Pediatric wide-field fundus photograph.
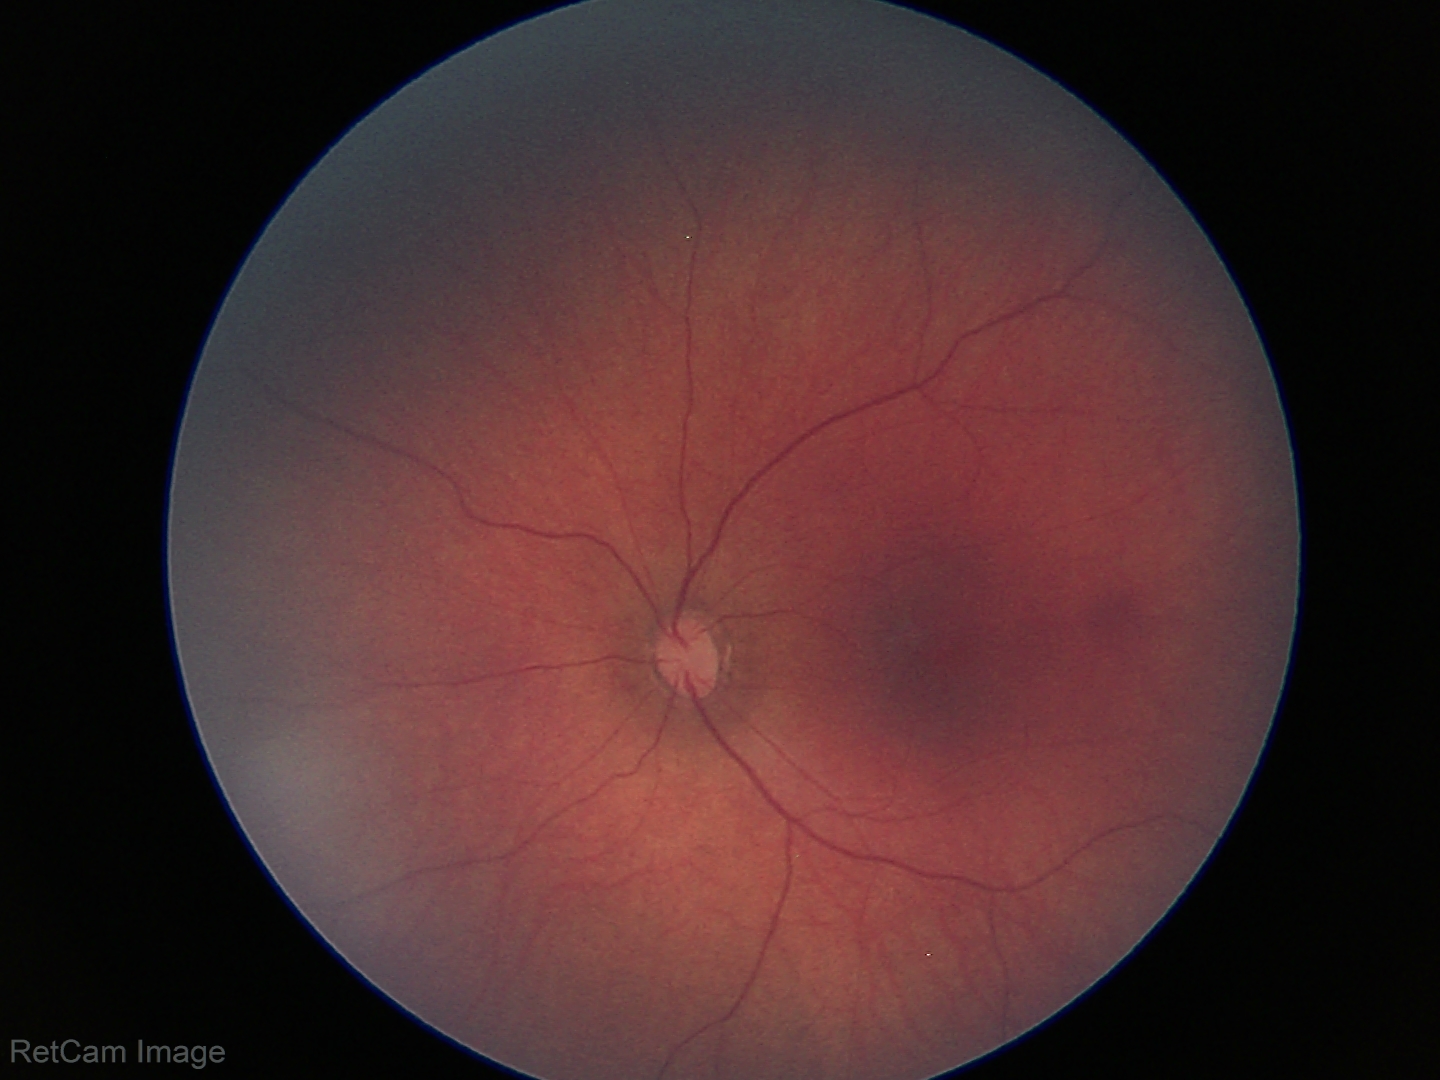
Screening examination diagnosed as physiological.